NIDEK AFC-230 fundus camera — 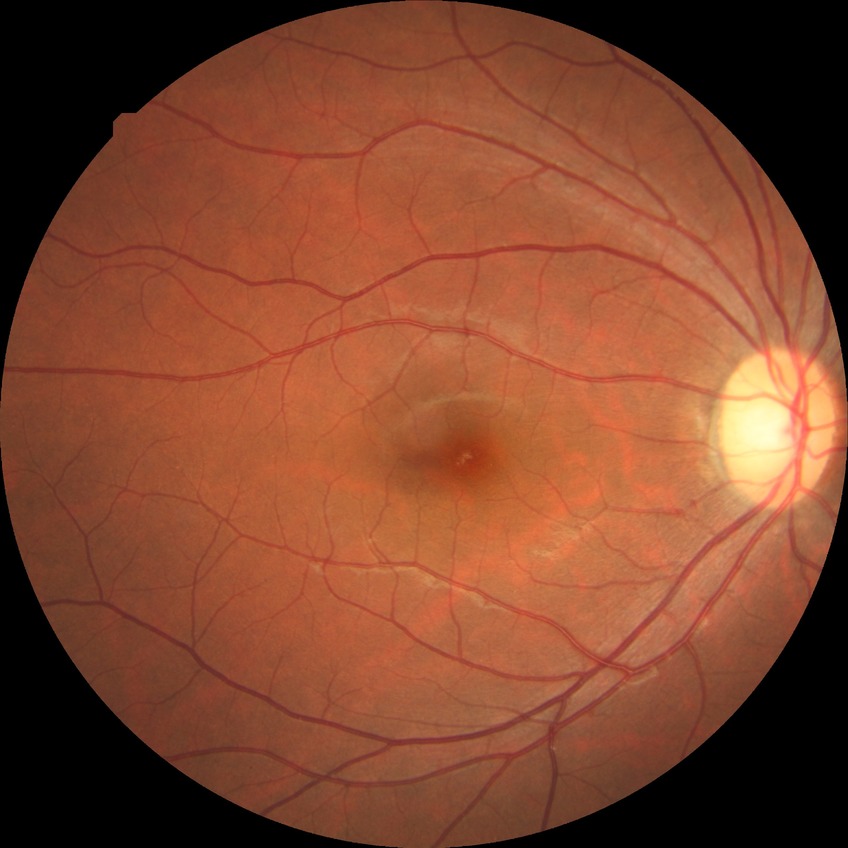
Retinopathy stage: no diabetic retinopathy.